Pediatric wide-field fundus photograph; acquired on the Clarity RetCam 3; image size 640x480.
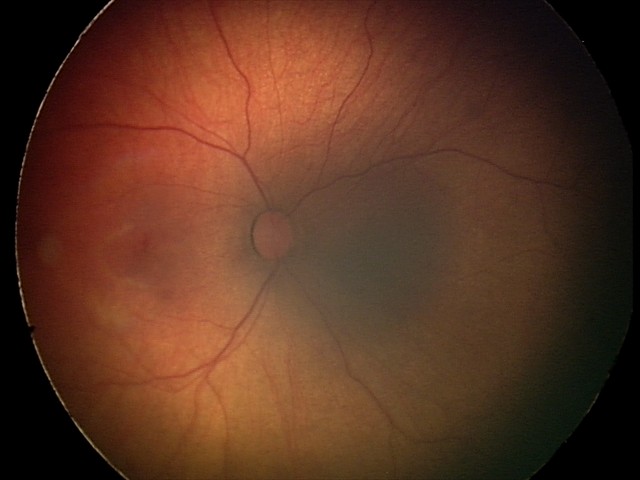 Diagnosis from this screening exam: retinal hemorrhages.